2212 by 1661 pixels: 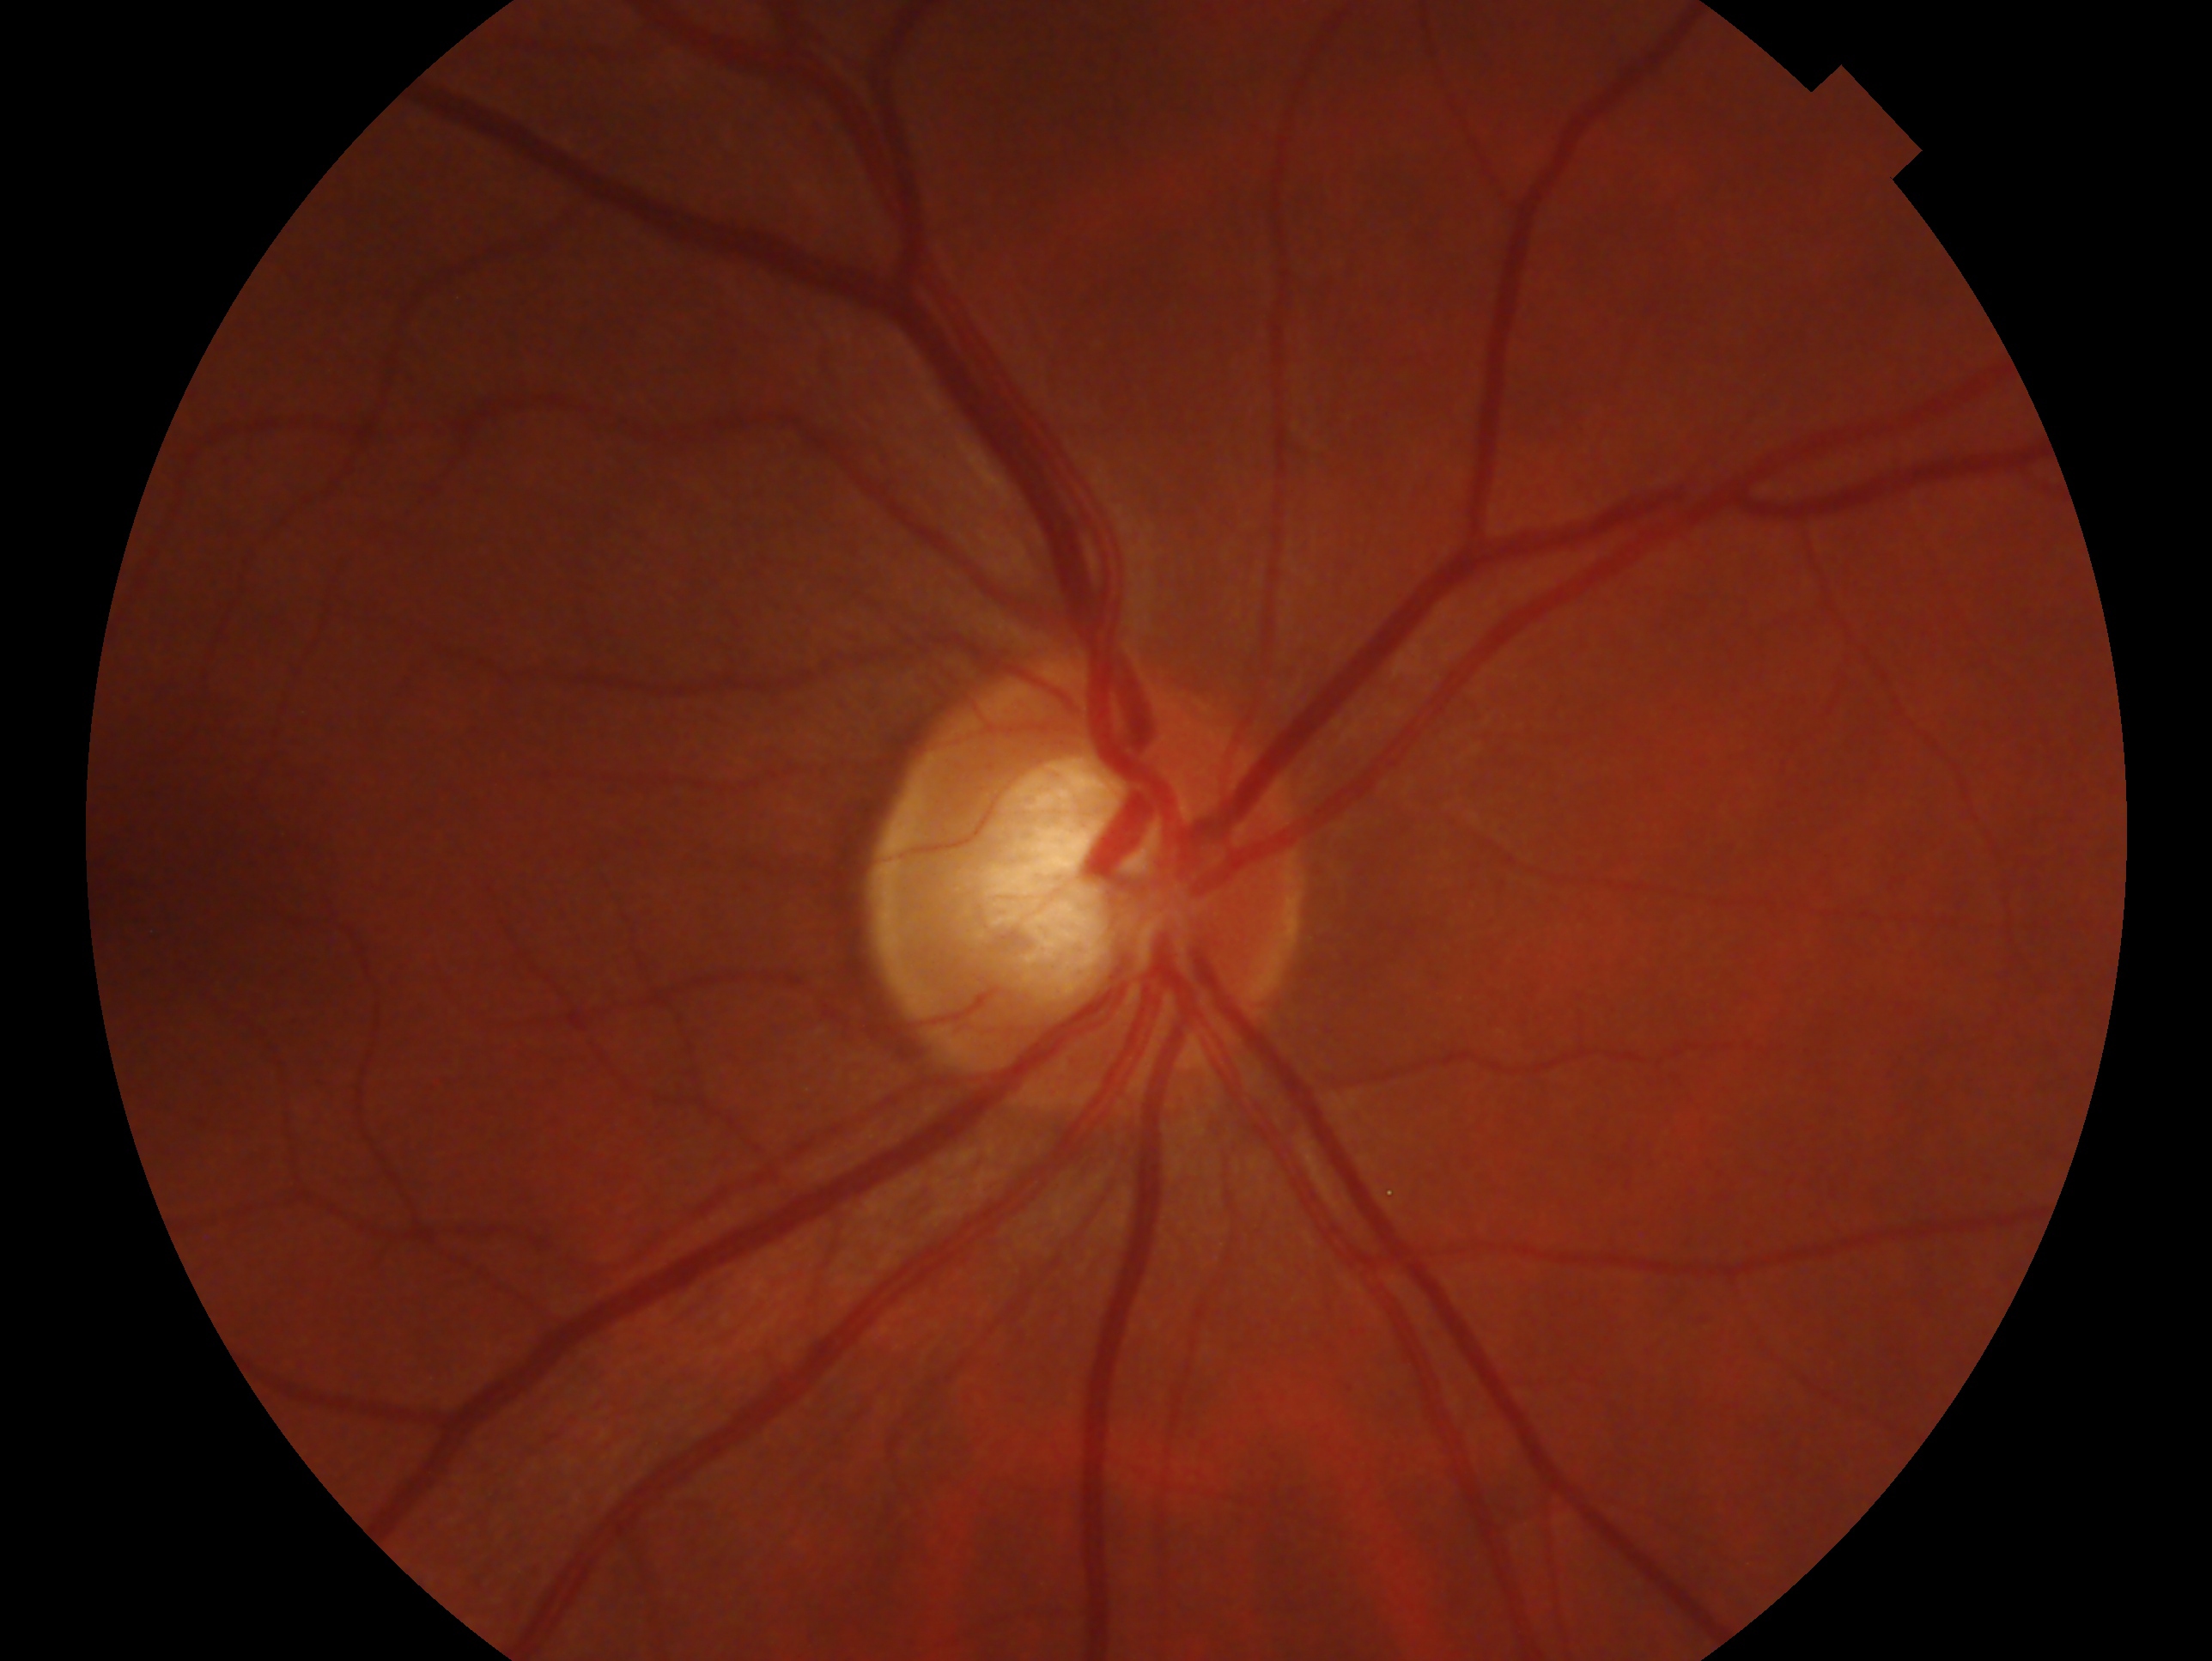 glaucoma diagnosis: cannot be excluded
laterality: right